35° FOV before cropping; disc-centered fundus crop.
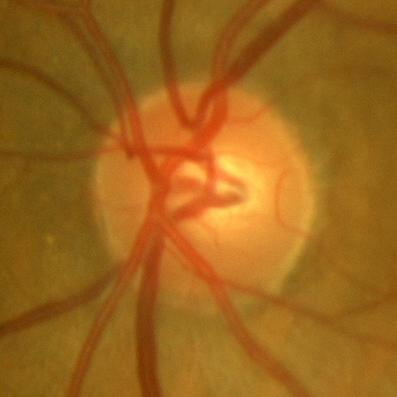

There is evidence of no glaucomatous changes.